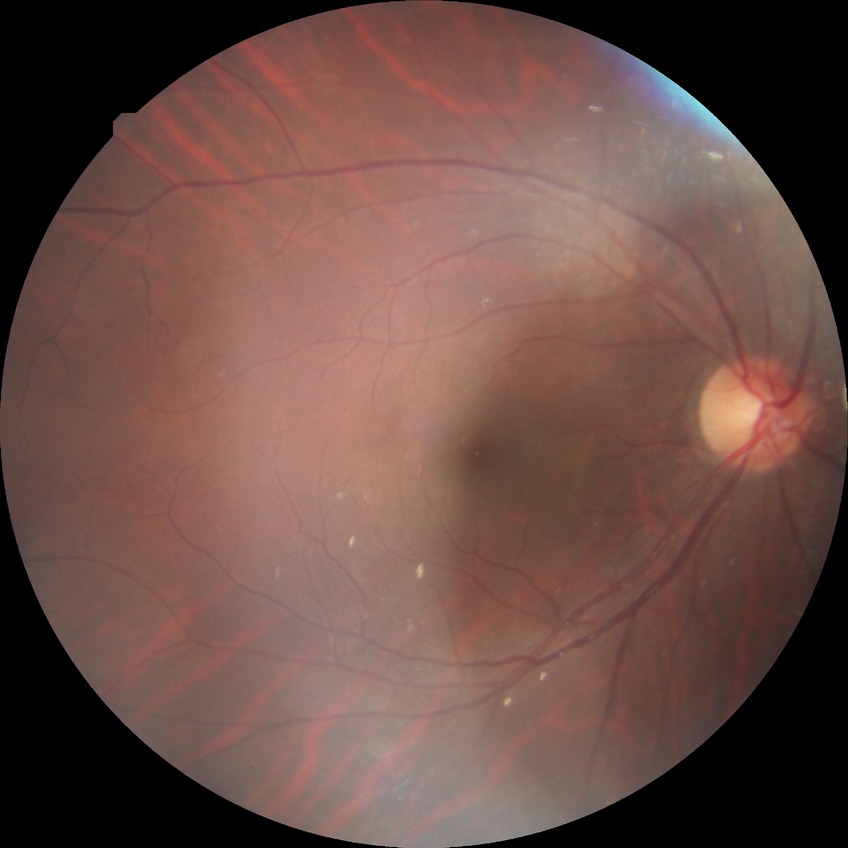

Retinopathy stage is no diabetic retinopathy.